45° field of view, color fundus photograph, 2184x1690px.
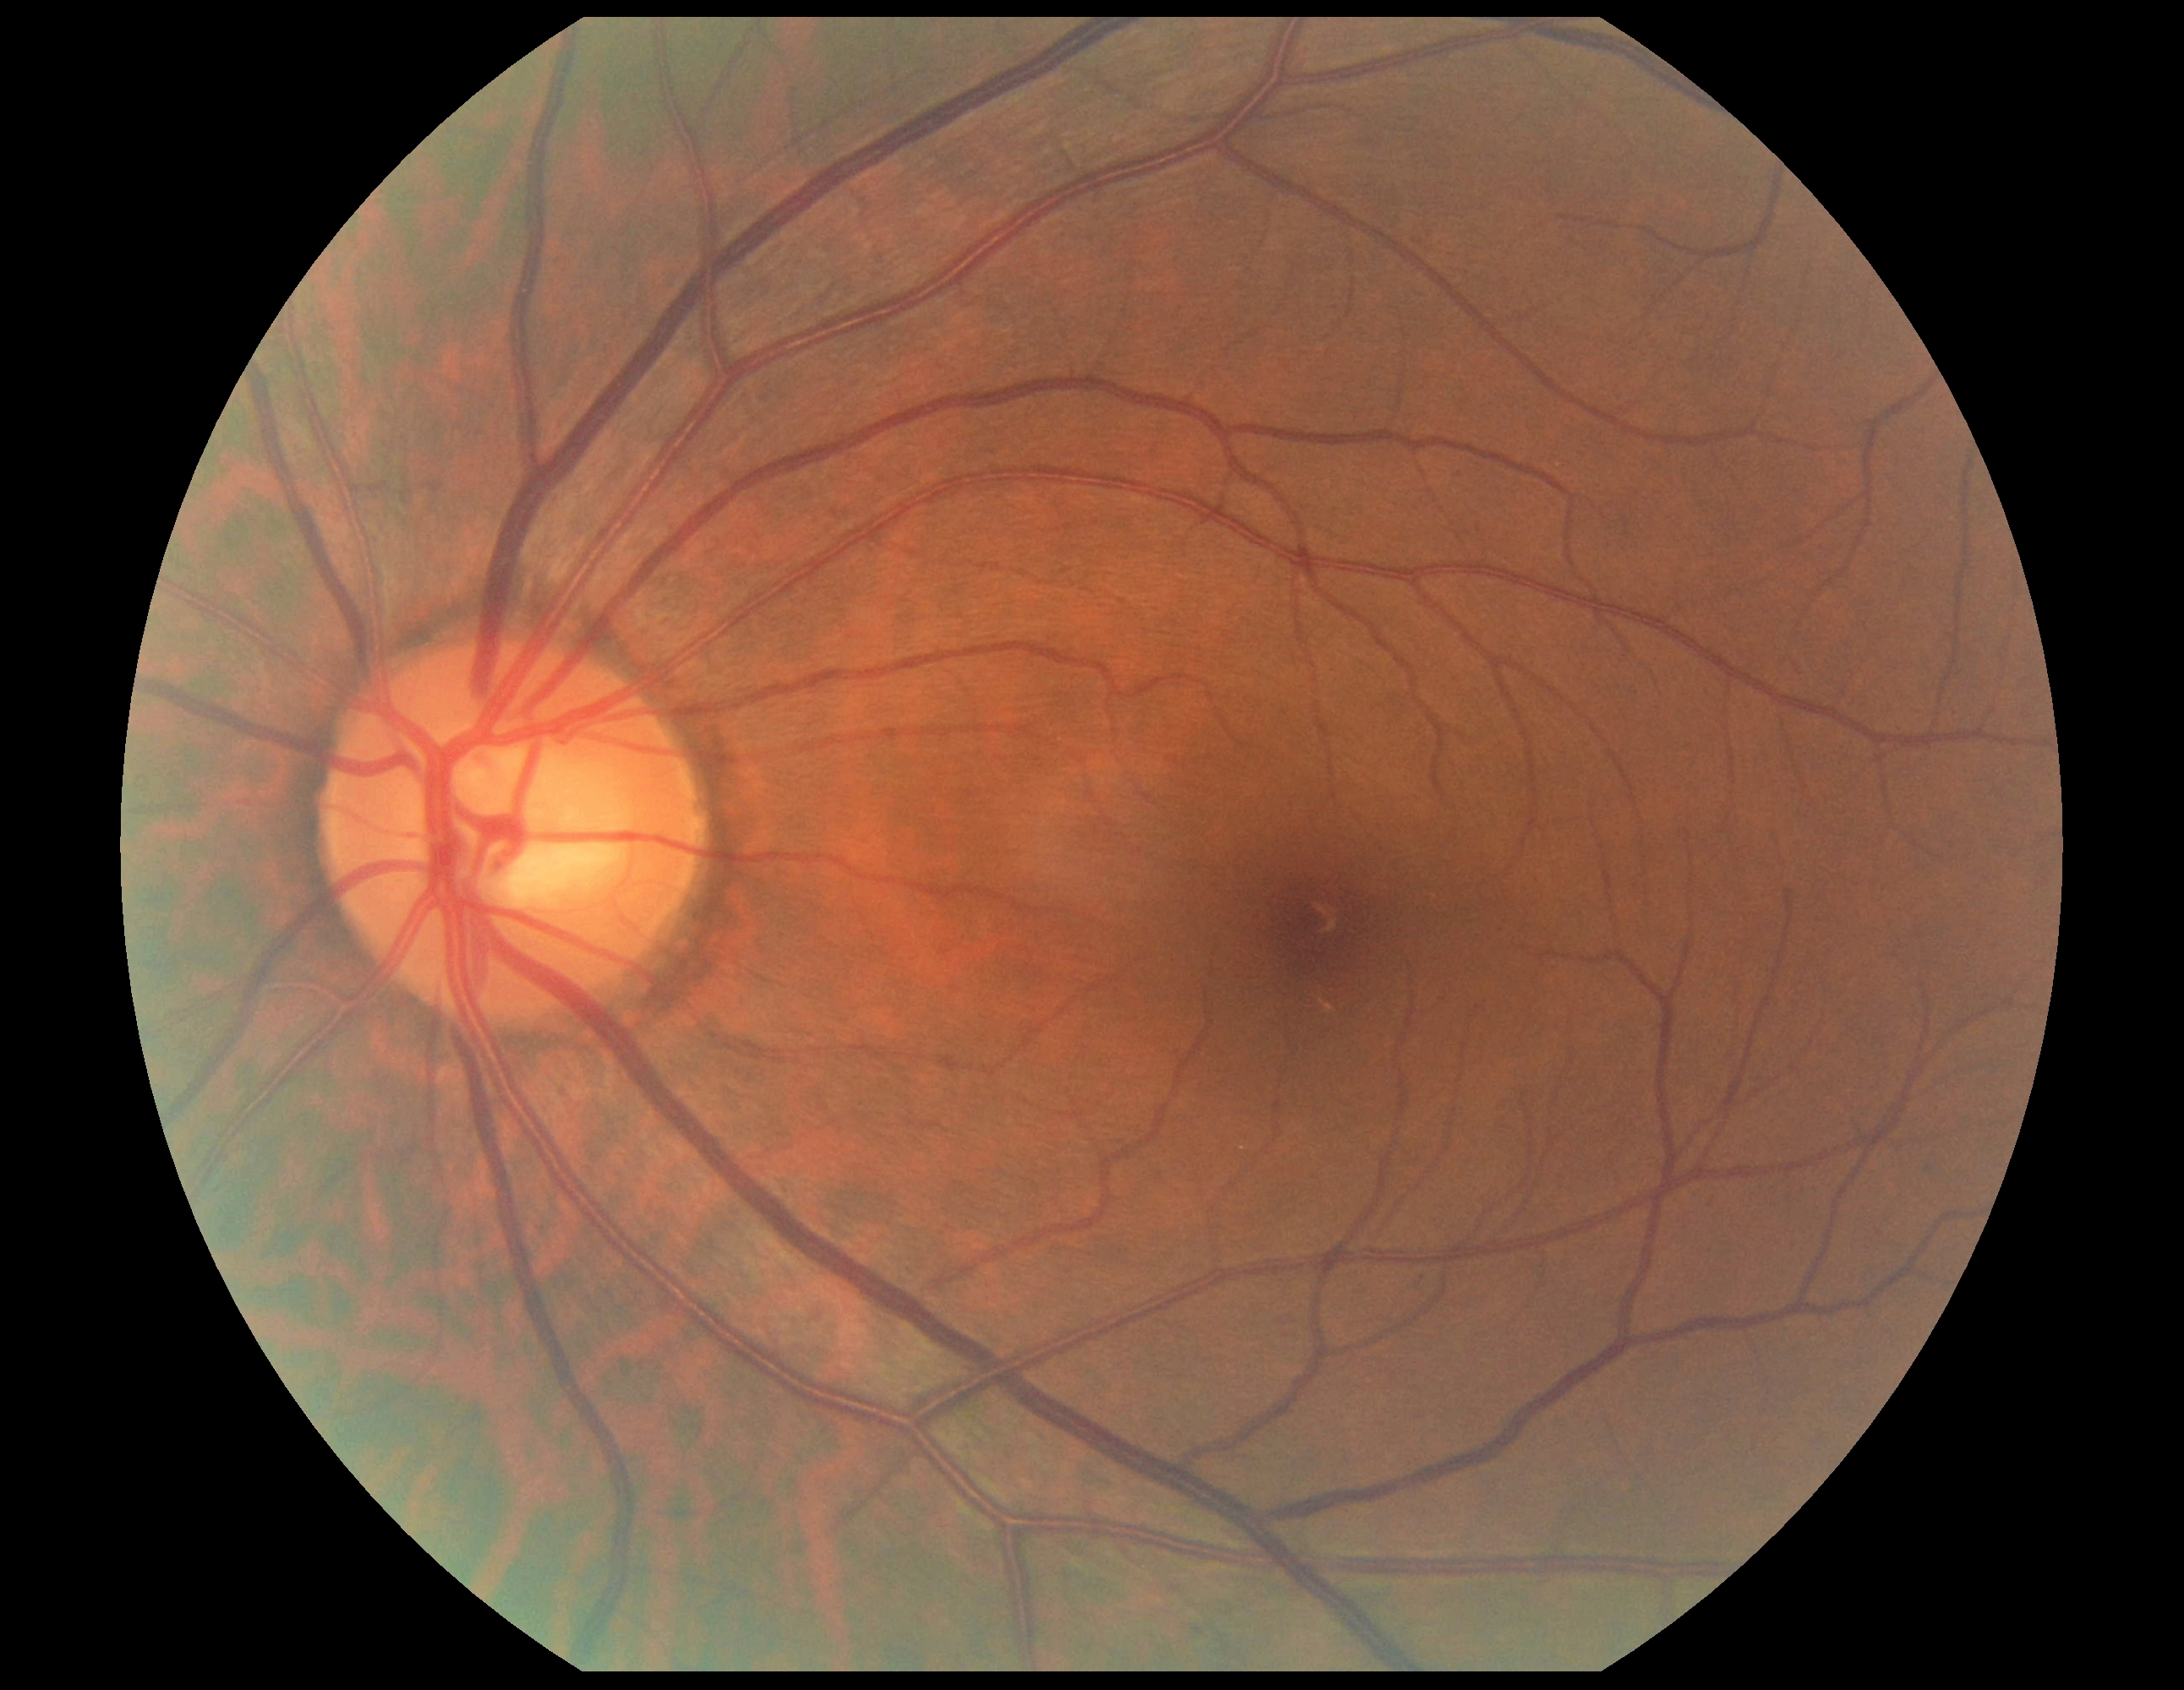

{
  "dr_impression": "no apparent DR",
  "dr_grade": "grade 0 (no apparent retinopathy)"
}